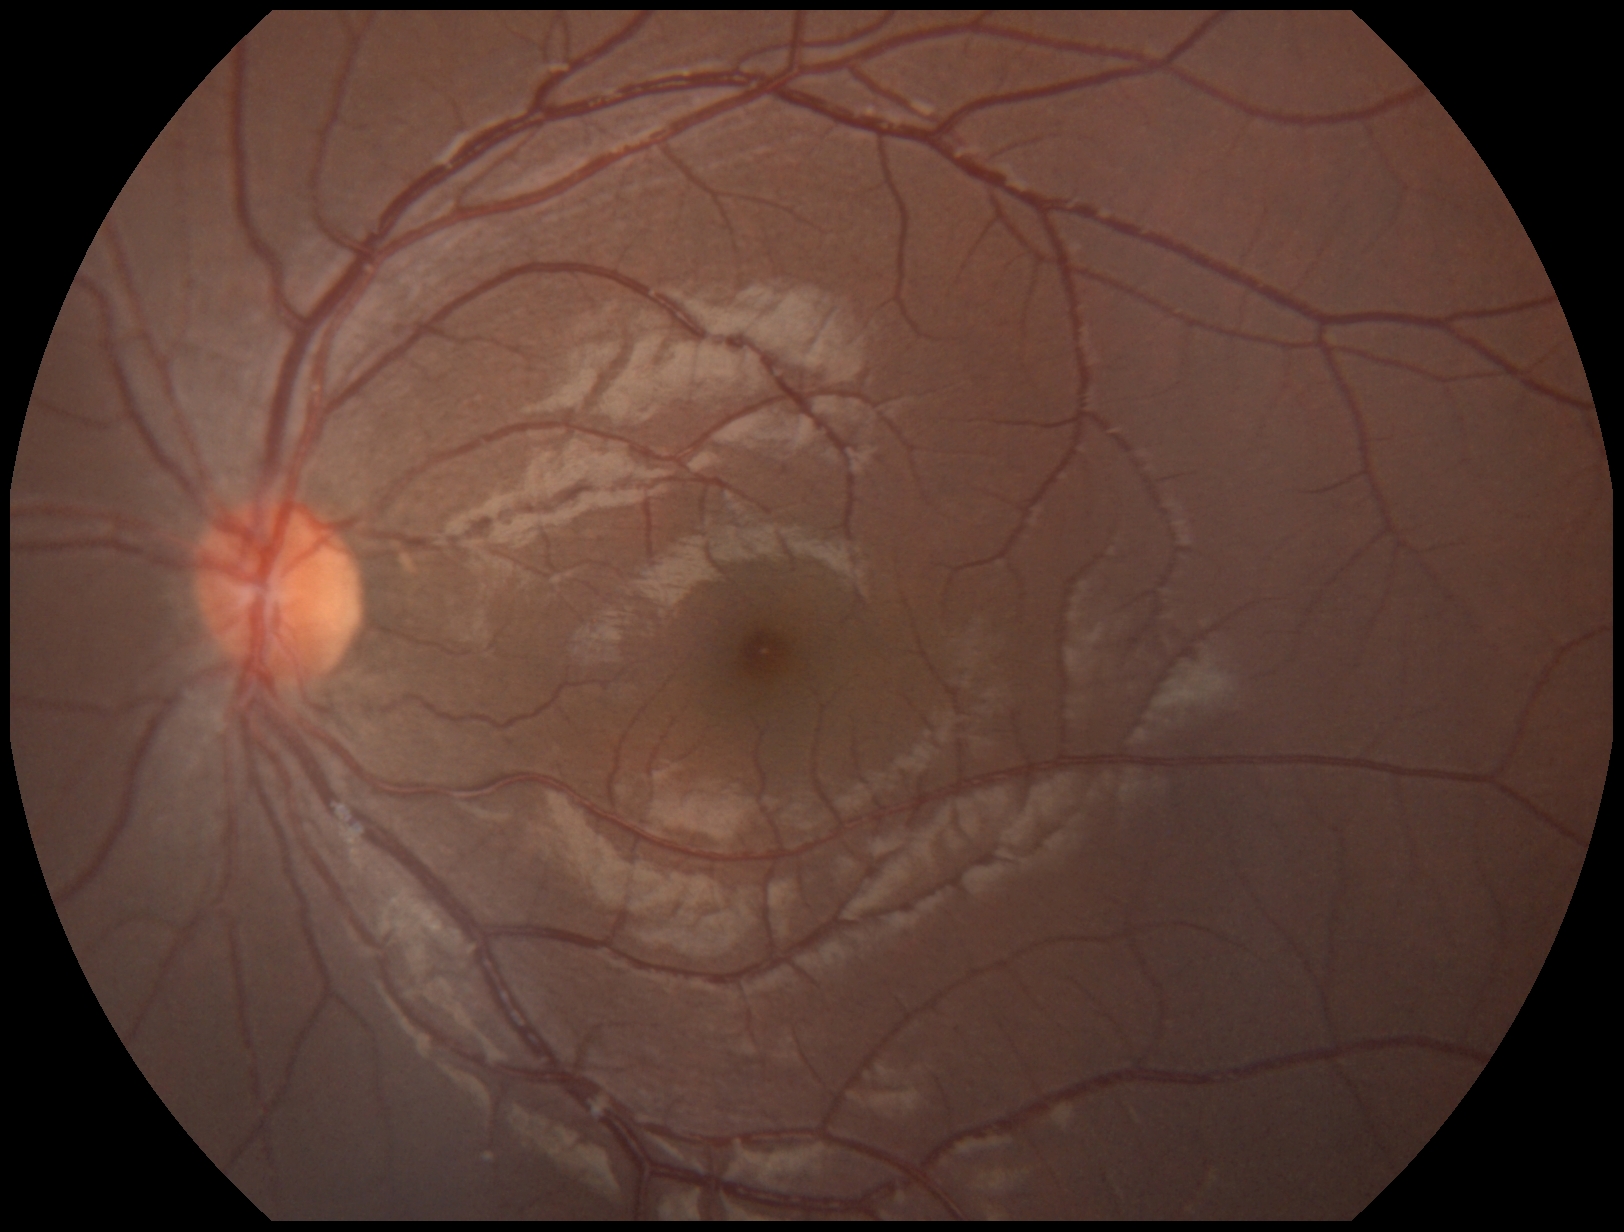

{"dr_grade": "0 (no apparent retinopathy)"}